Image size 848x848:
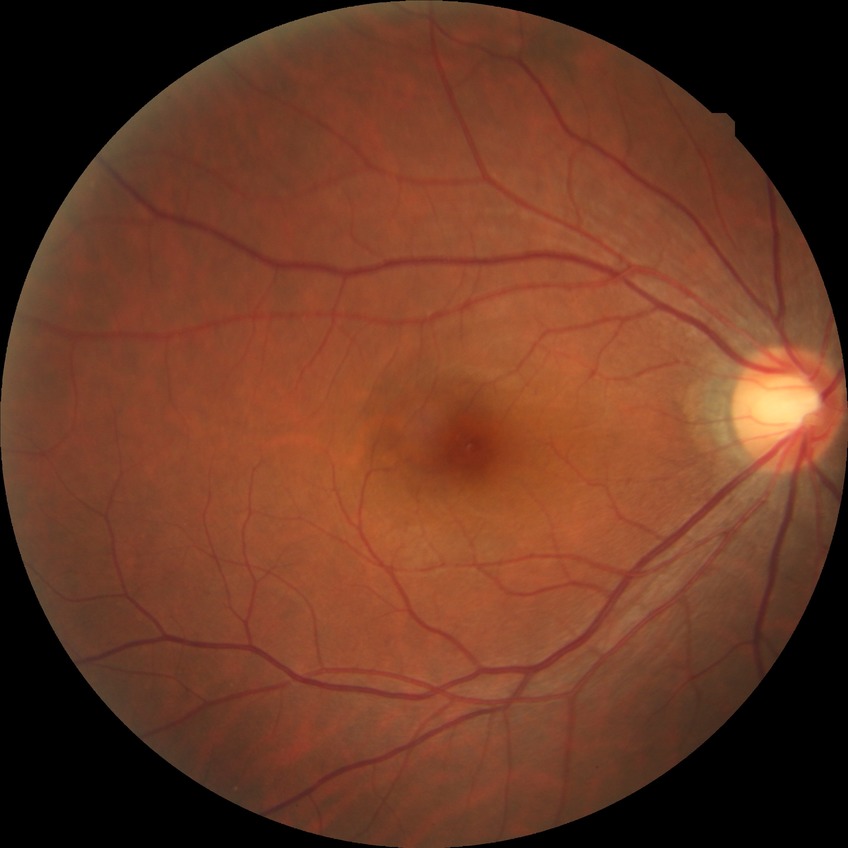
Diabetic retinopathy (DR) is no diabetic retinopathy (NDR).